Phoenix ICON, 100° FOV · infant wide-field retinal image: 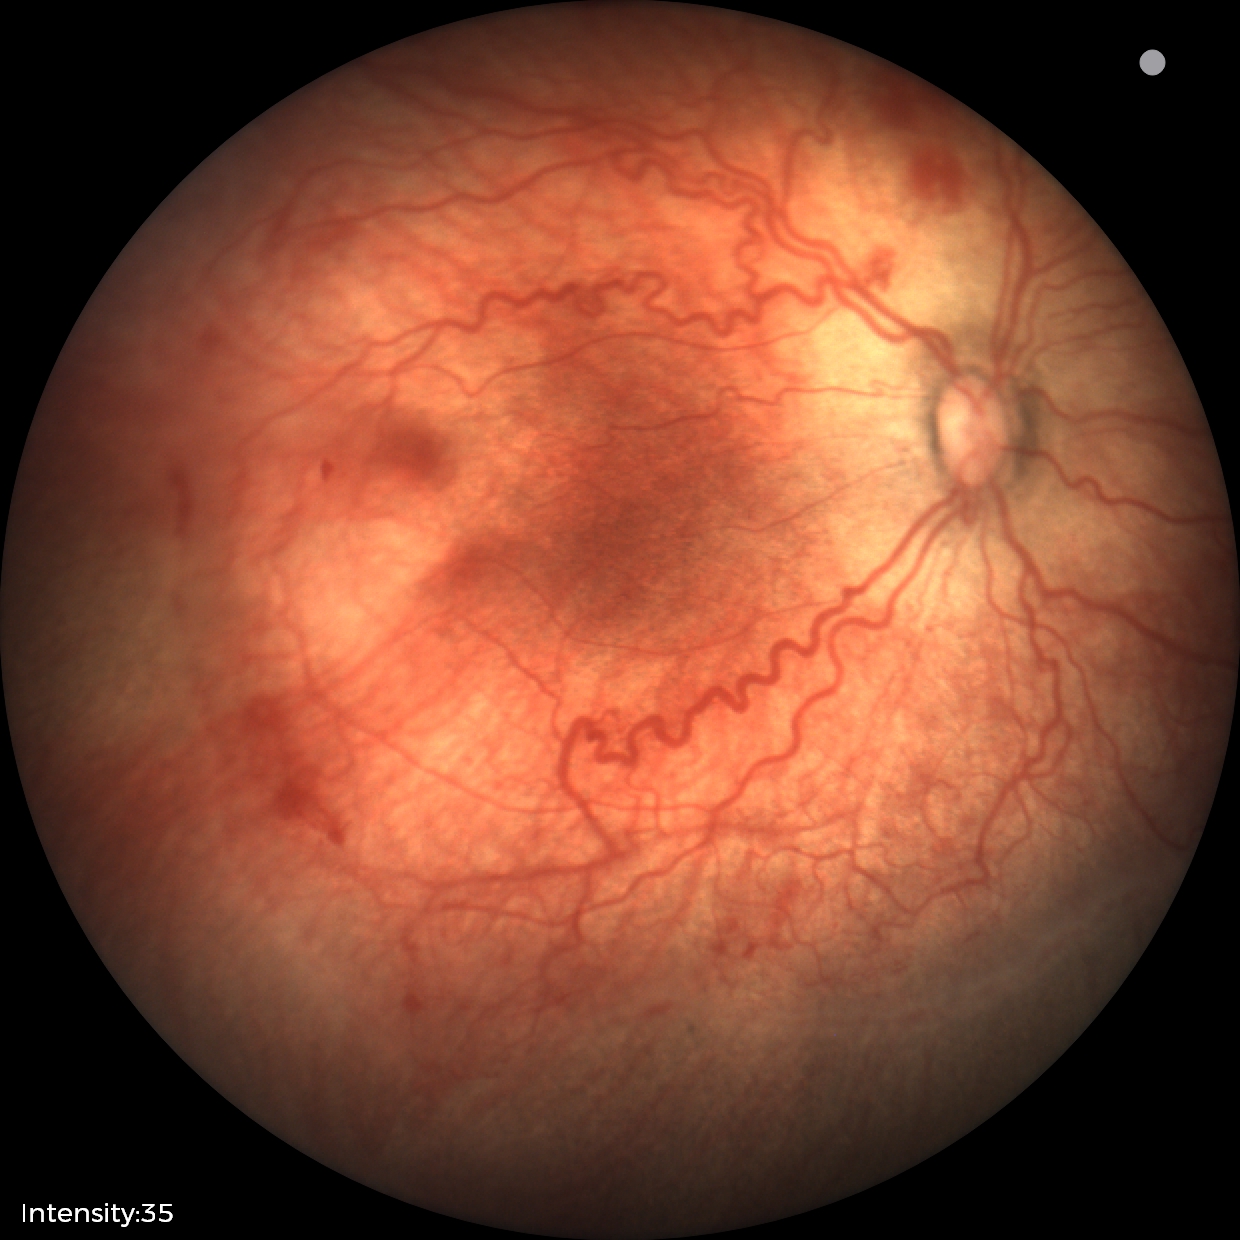
Assessment: retinopathy of prematurity (ROP) stage 2.